45-degree field of view. Color fundus photograph:
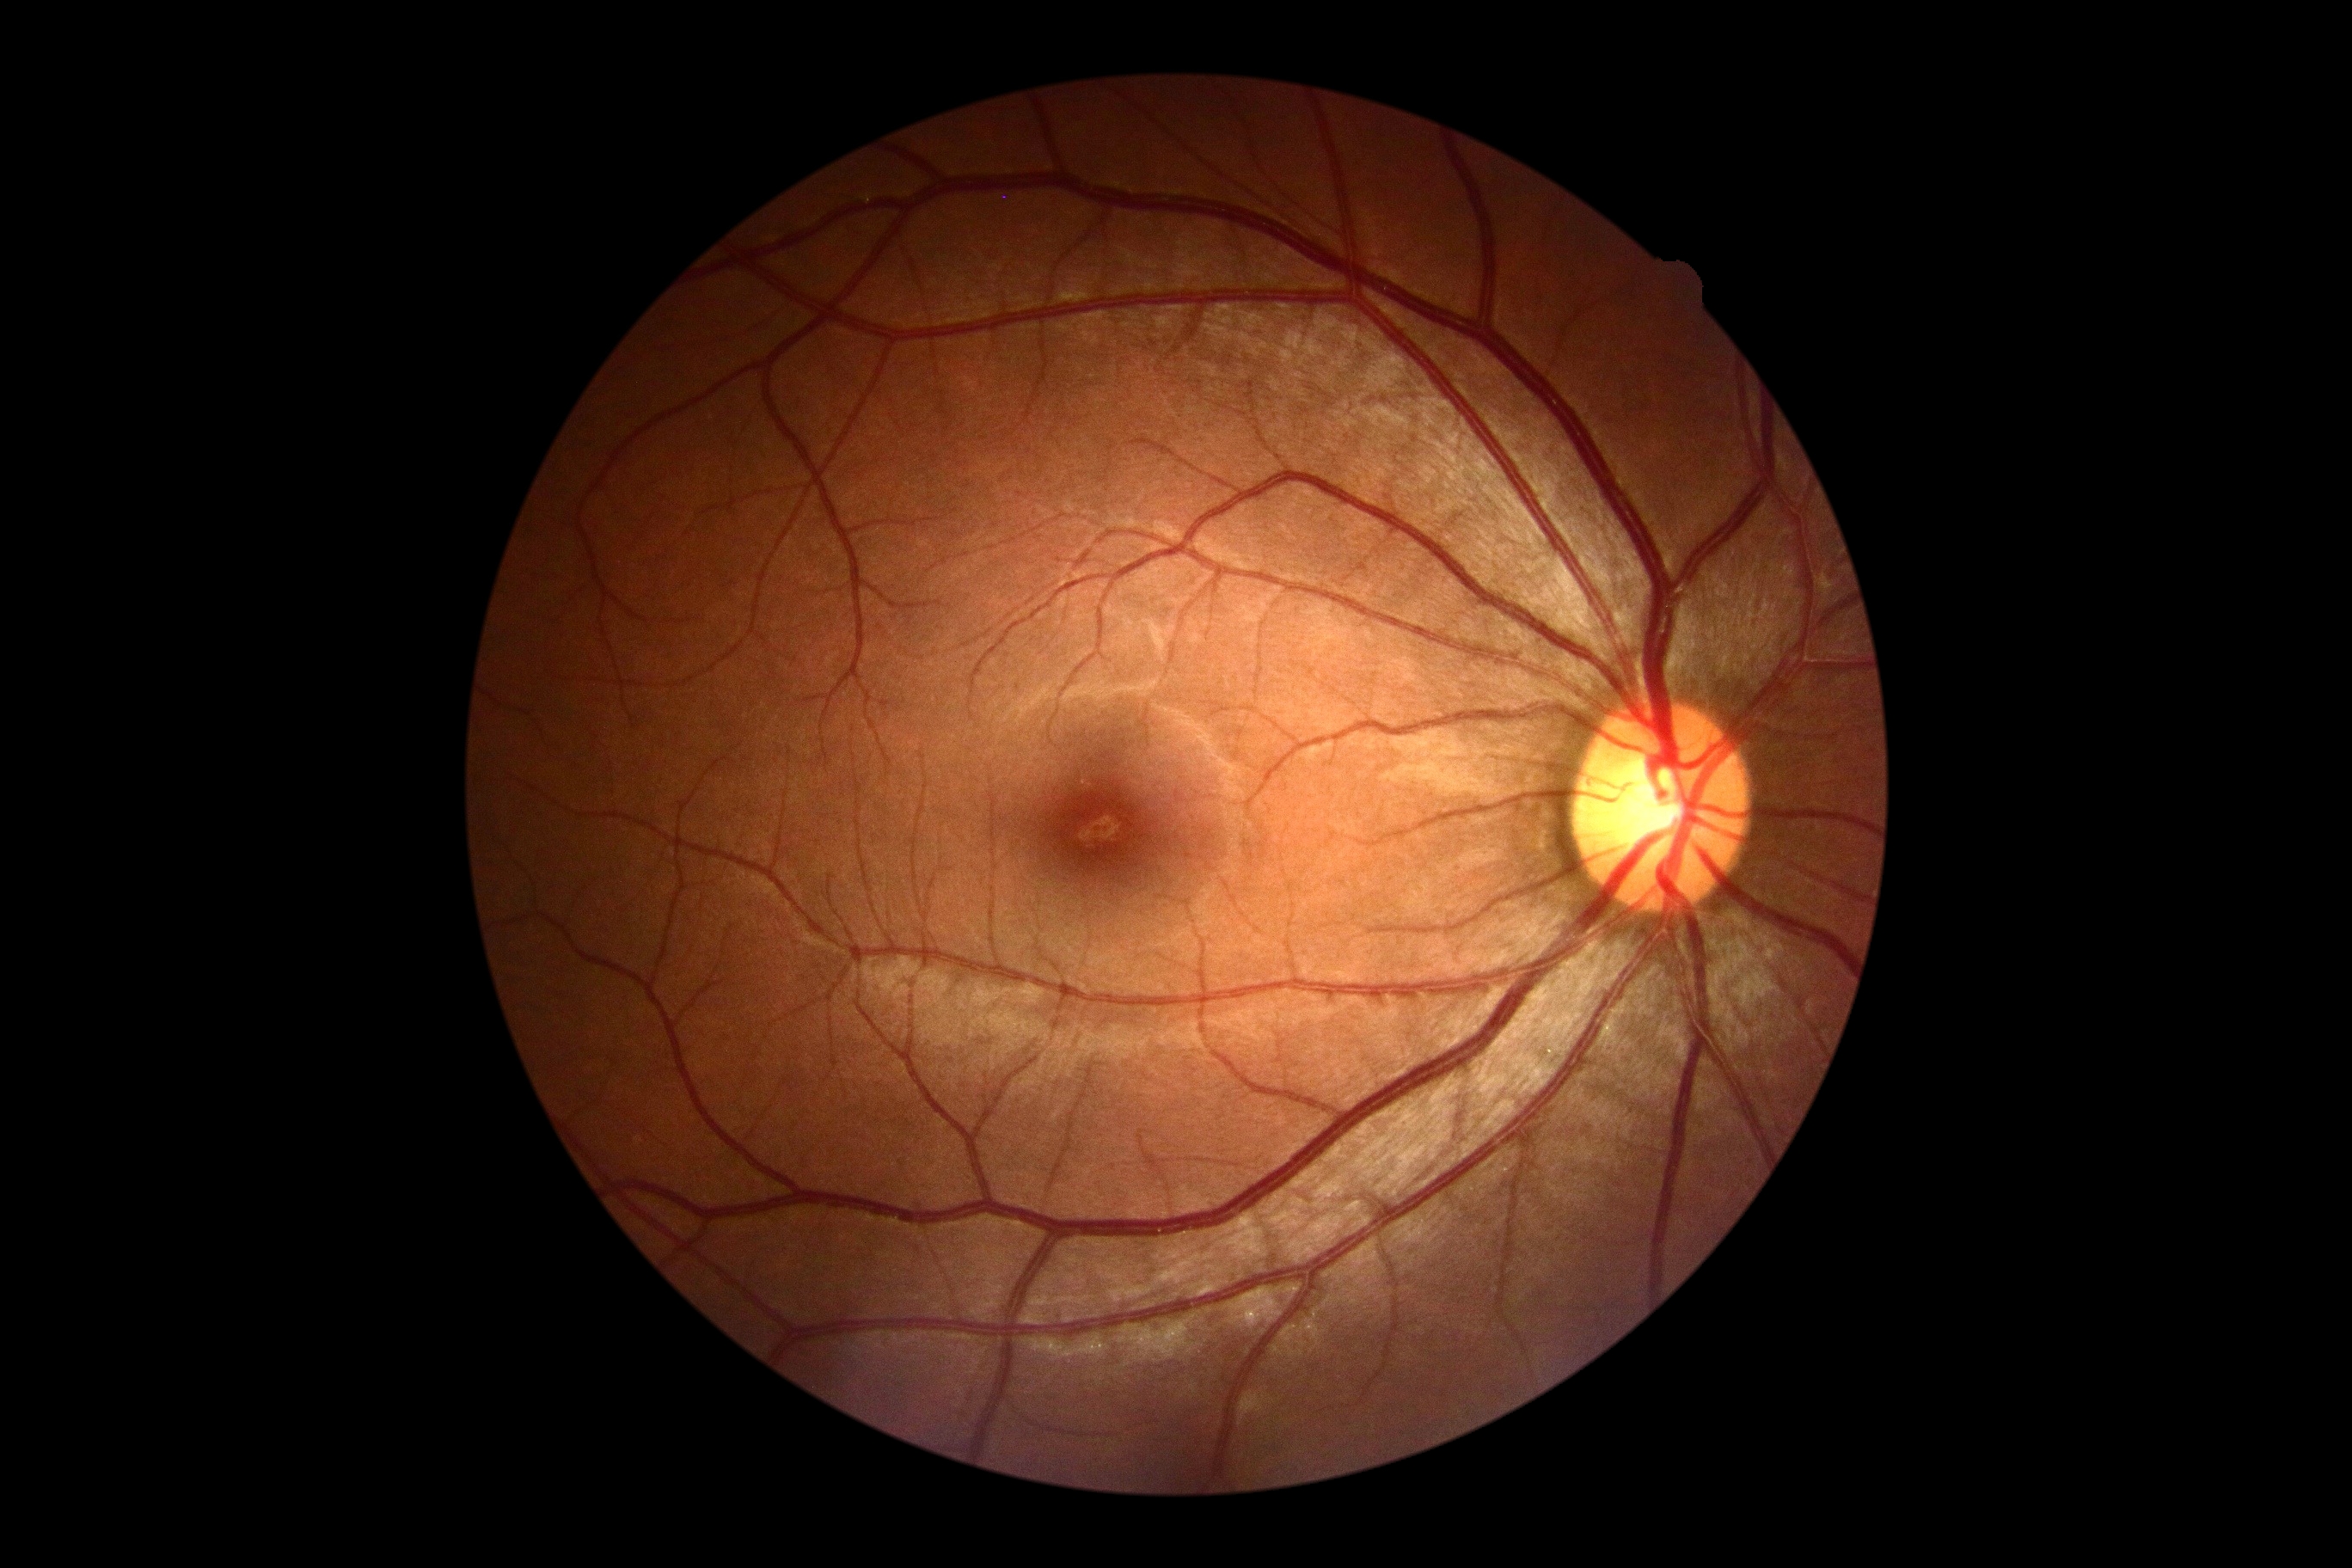 DR grade@0, DR impression@no apparent DR.